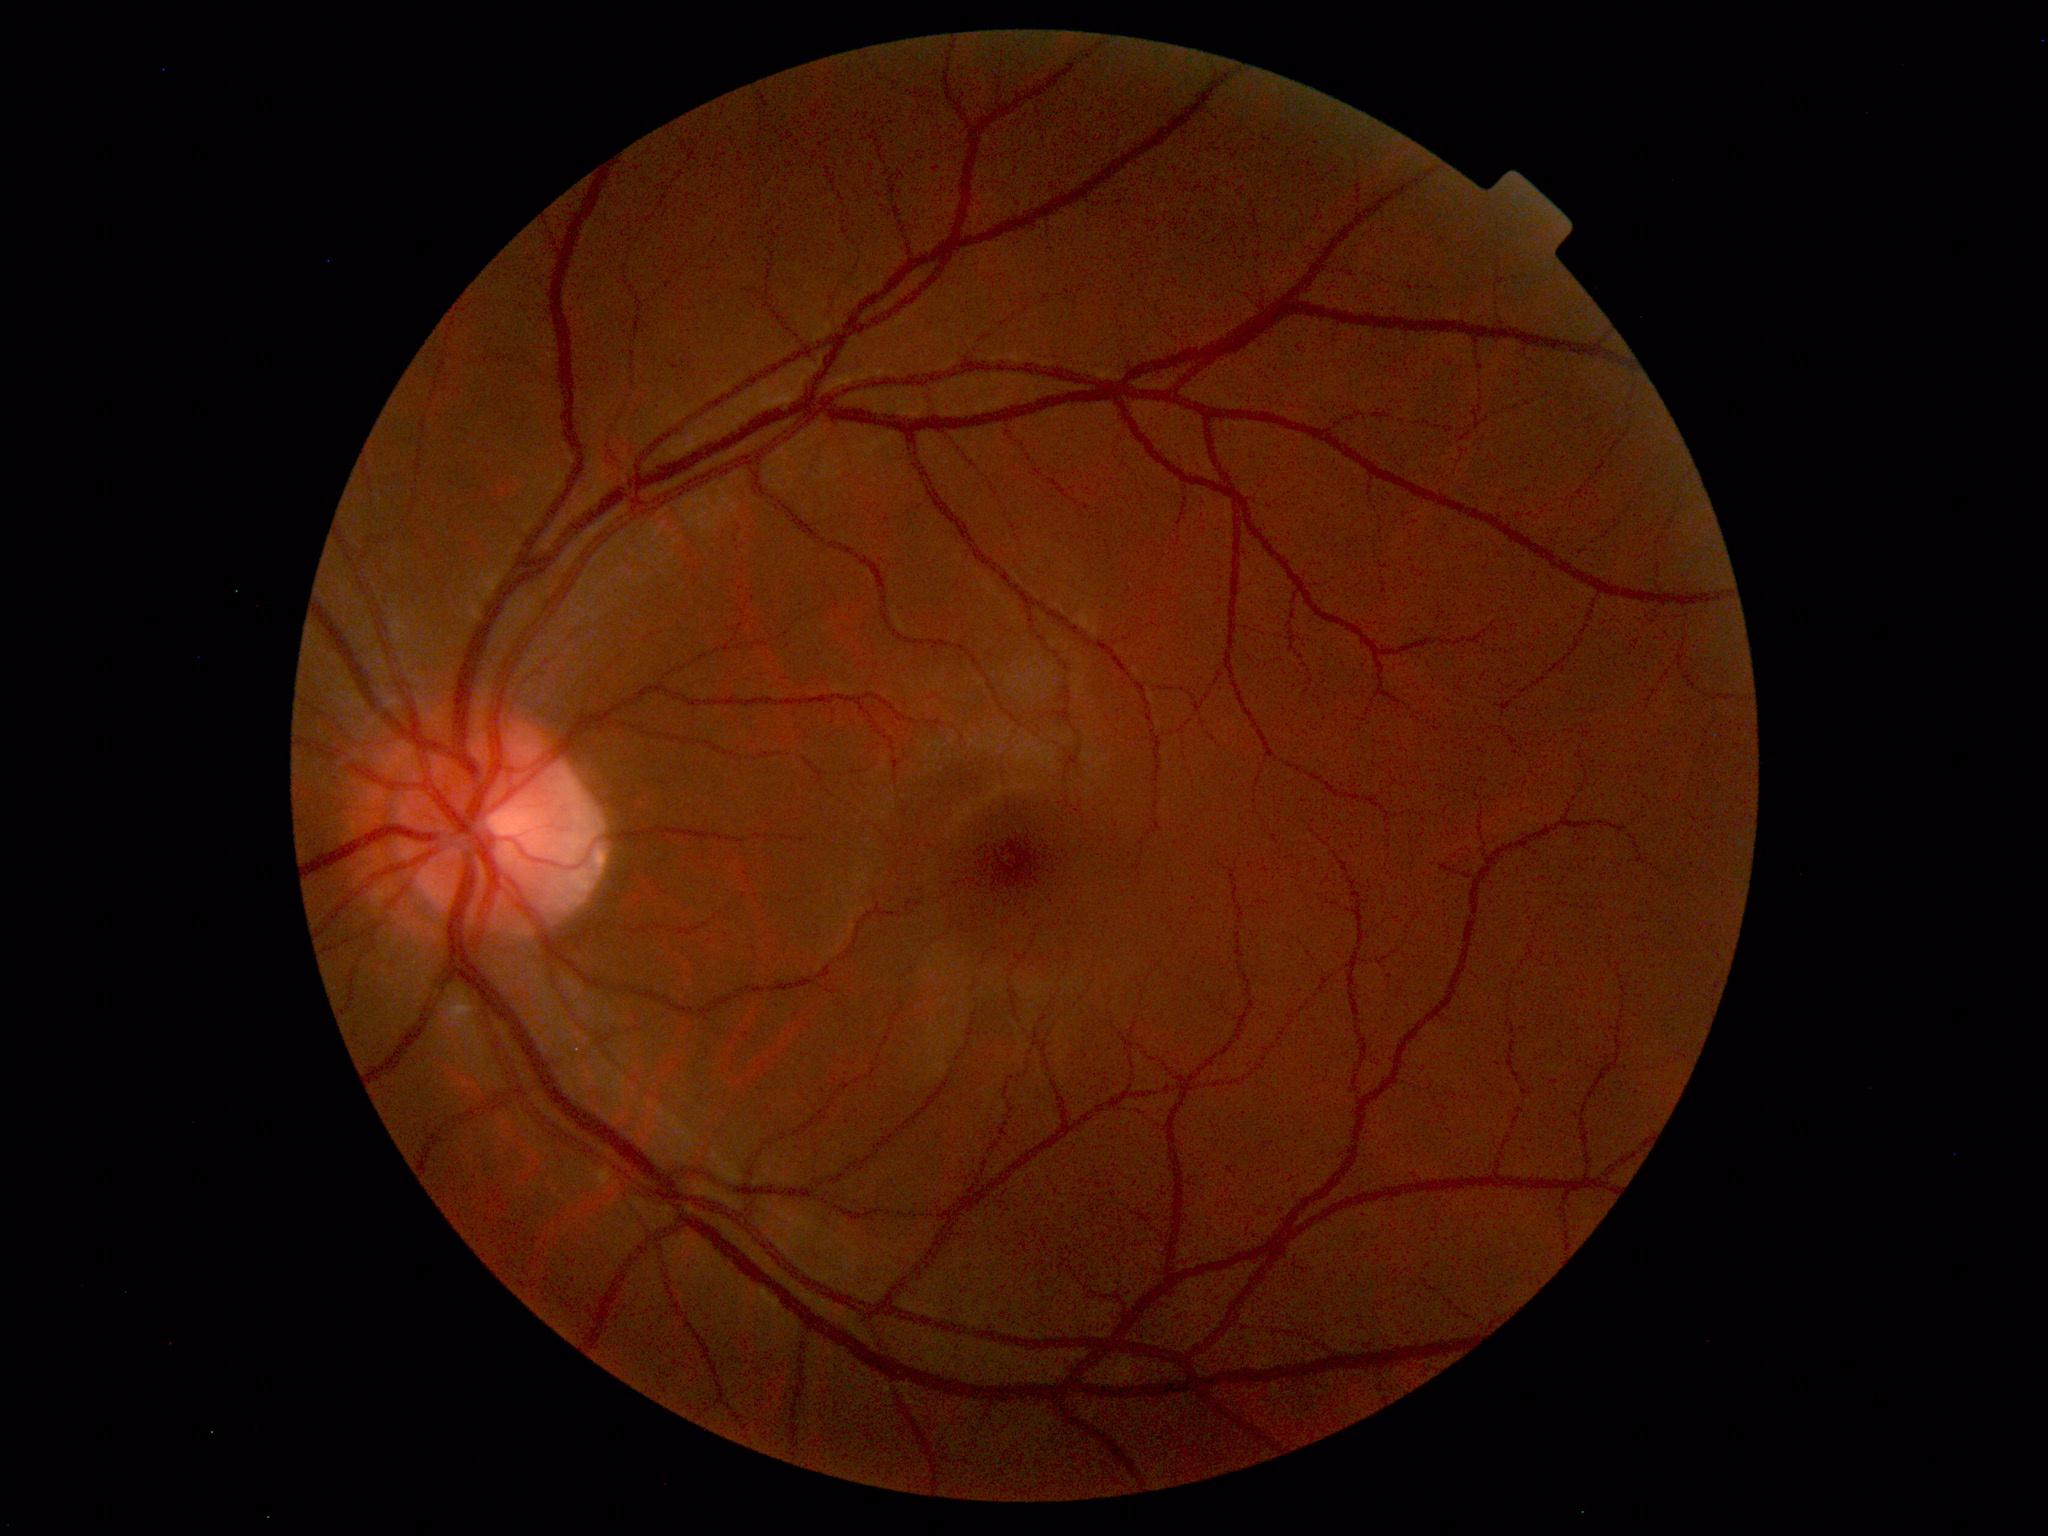

Normal retinal fundus image with no abnormalities identified.